2048 by 1536 pixels
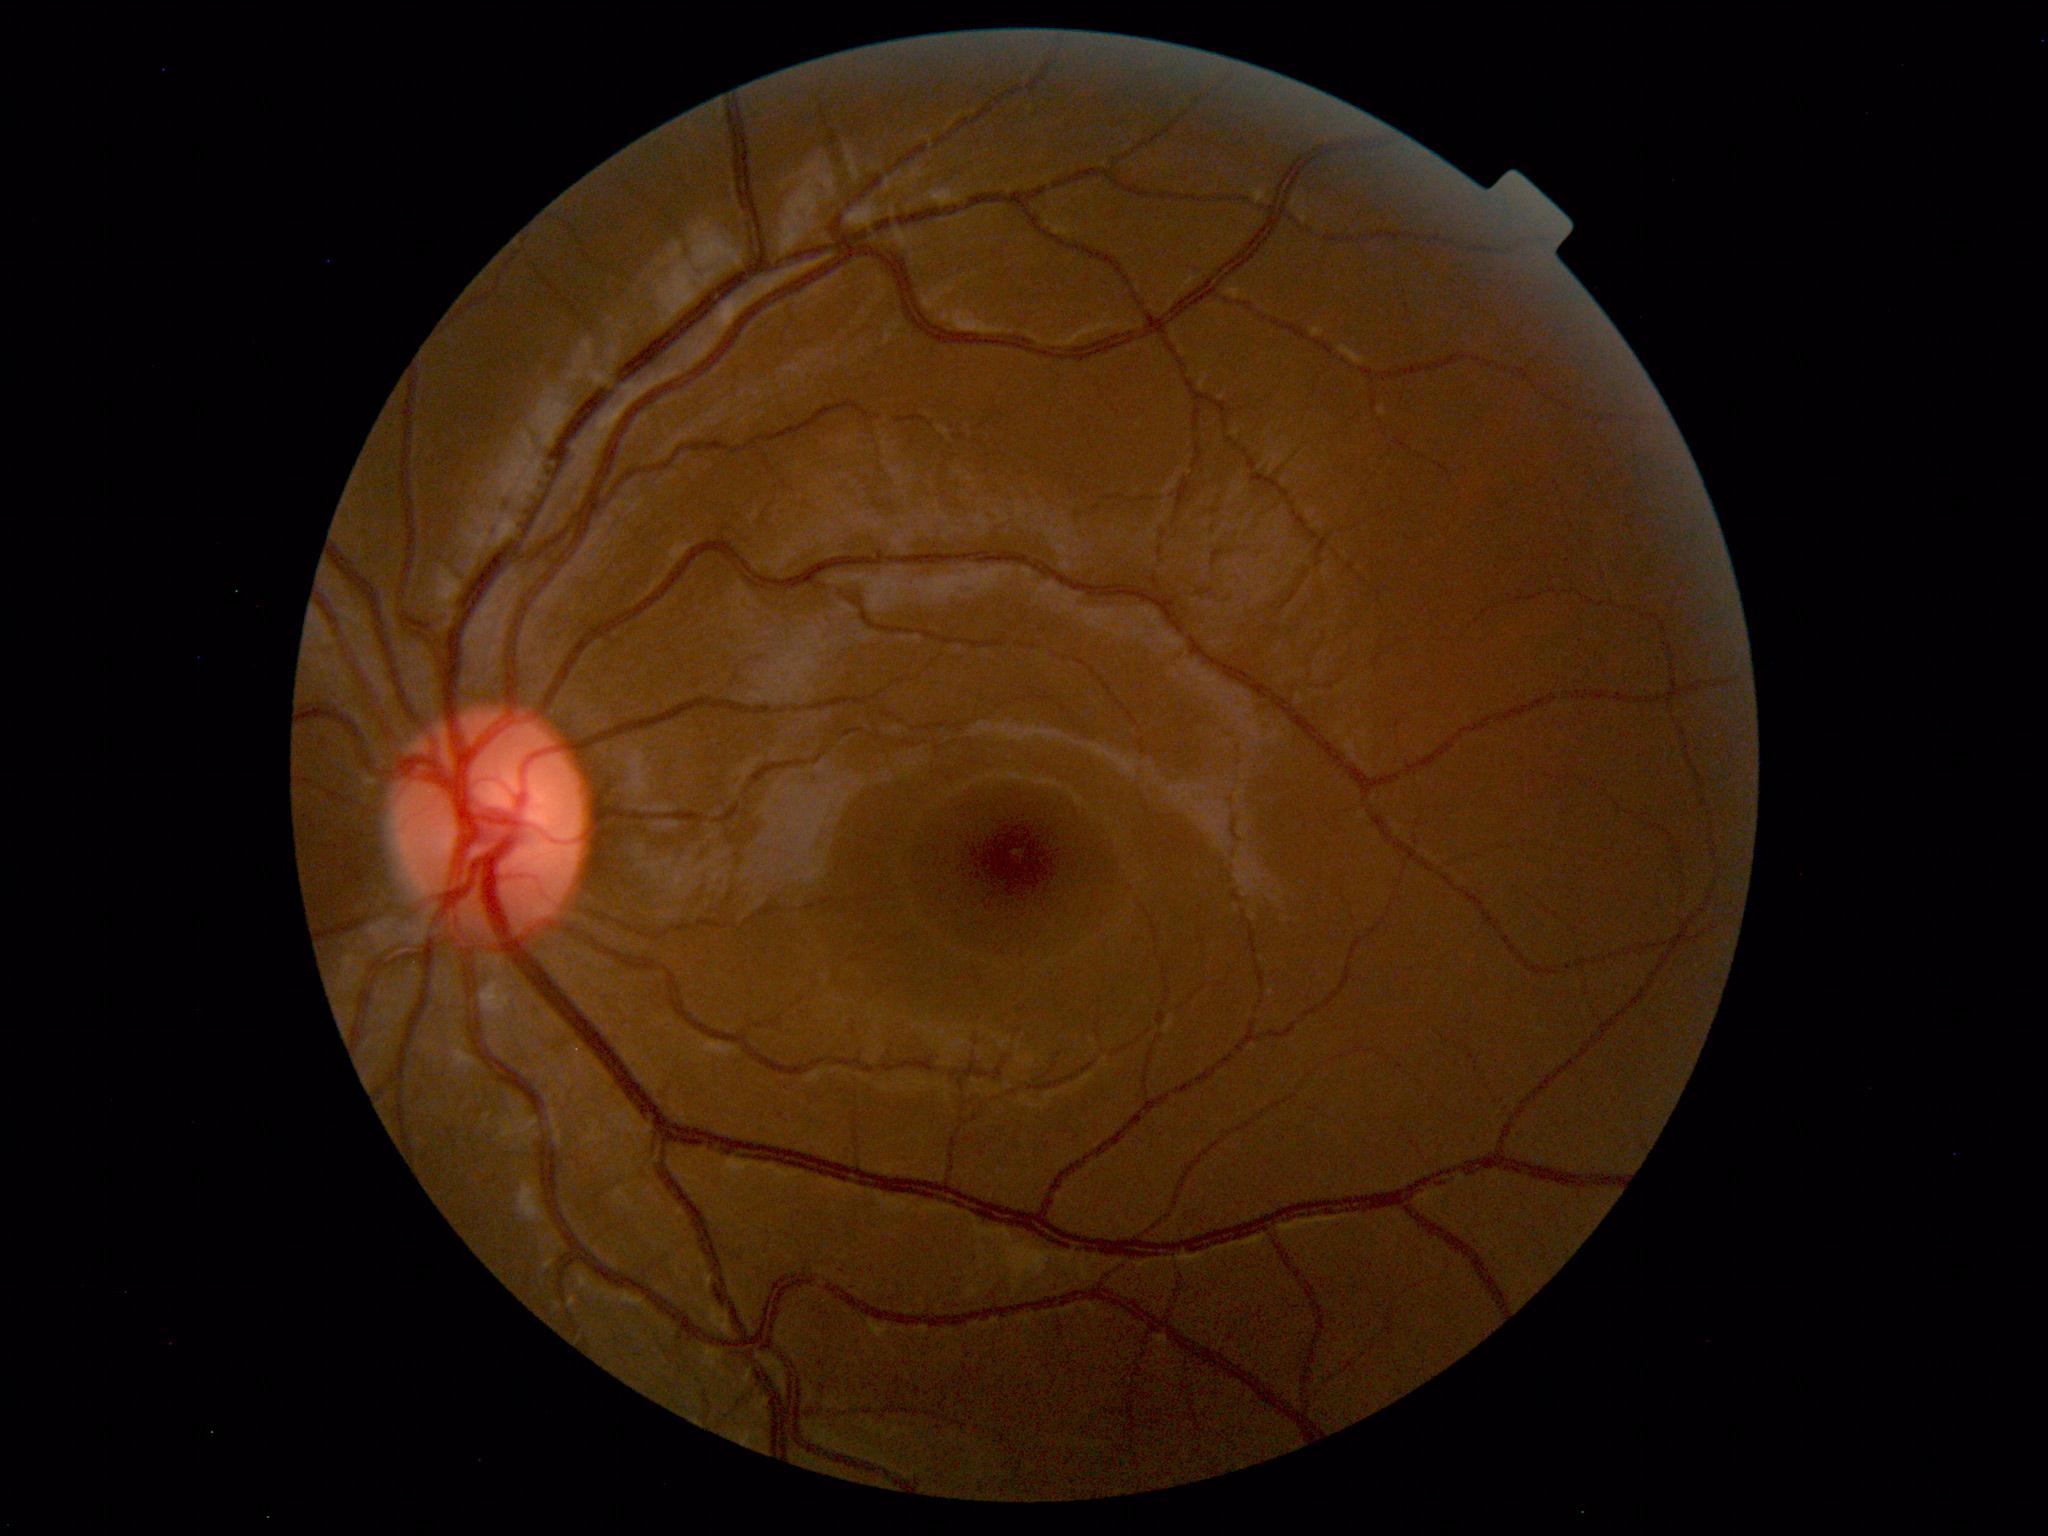
Impression: normal fundus.